FOV: 45 degrees; 2352 by 1568 pixels; color fundus photograph:
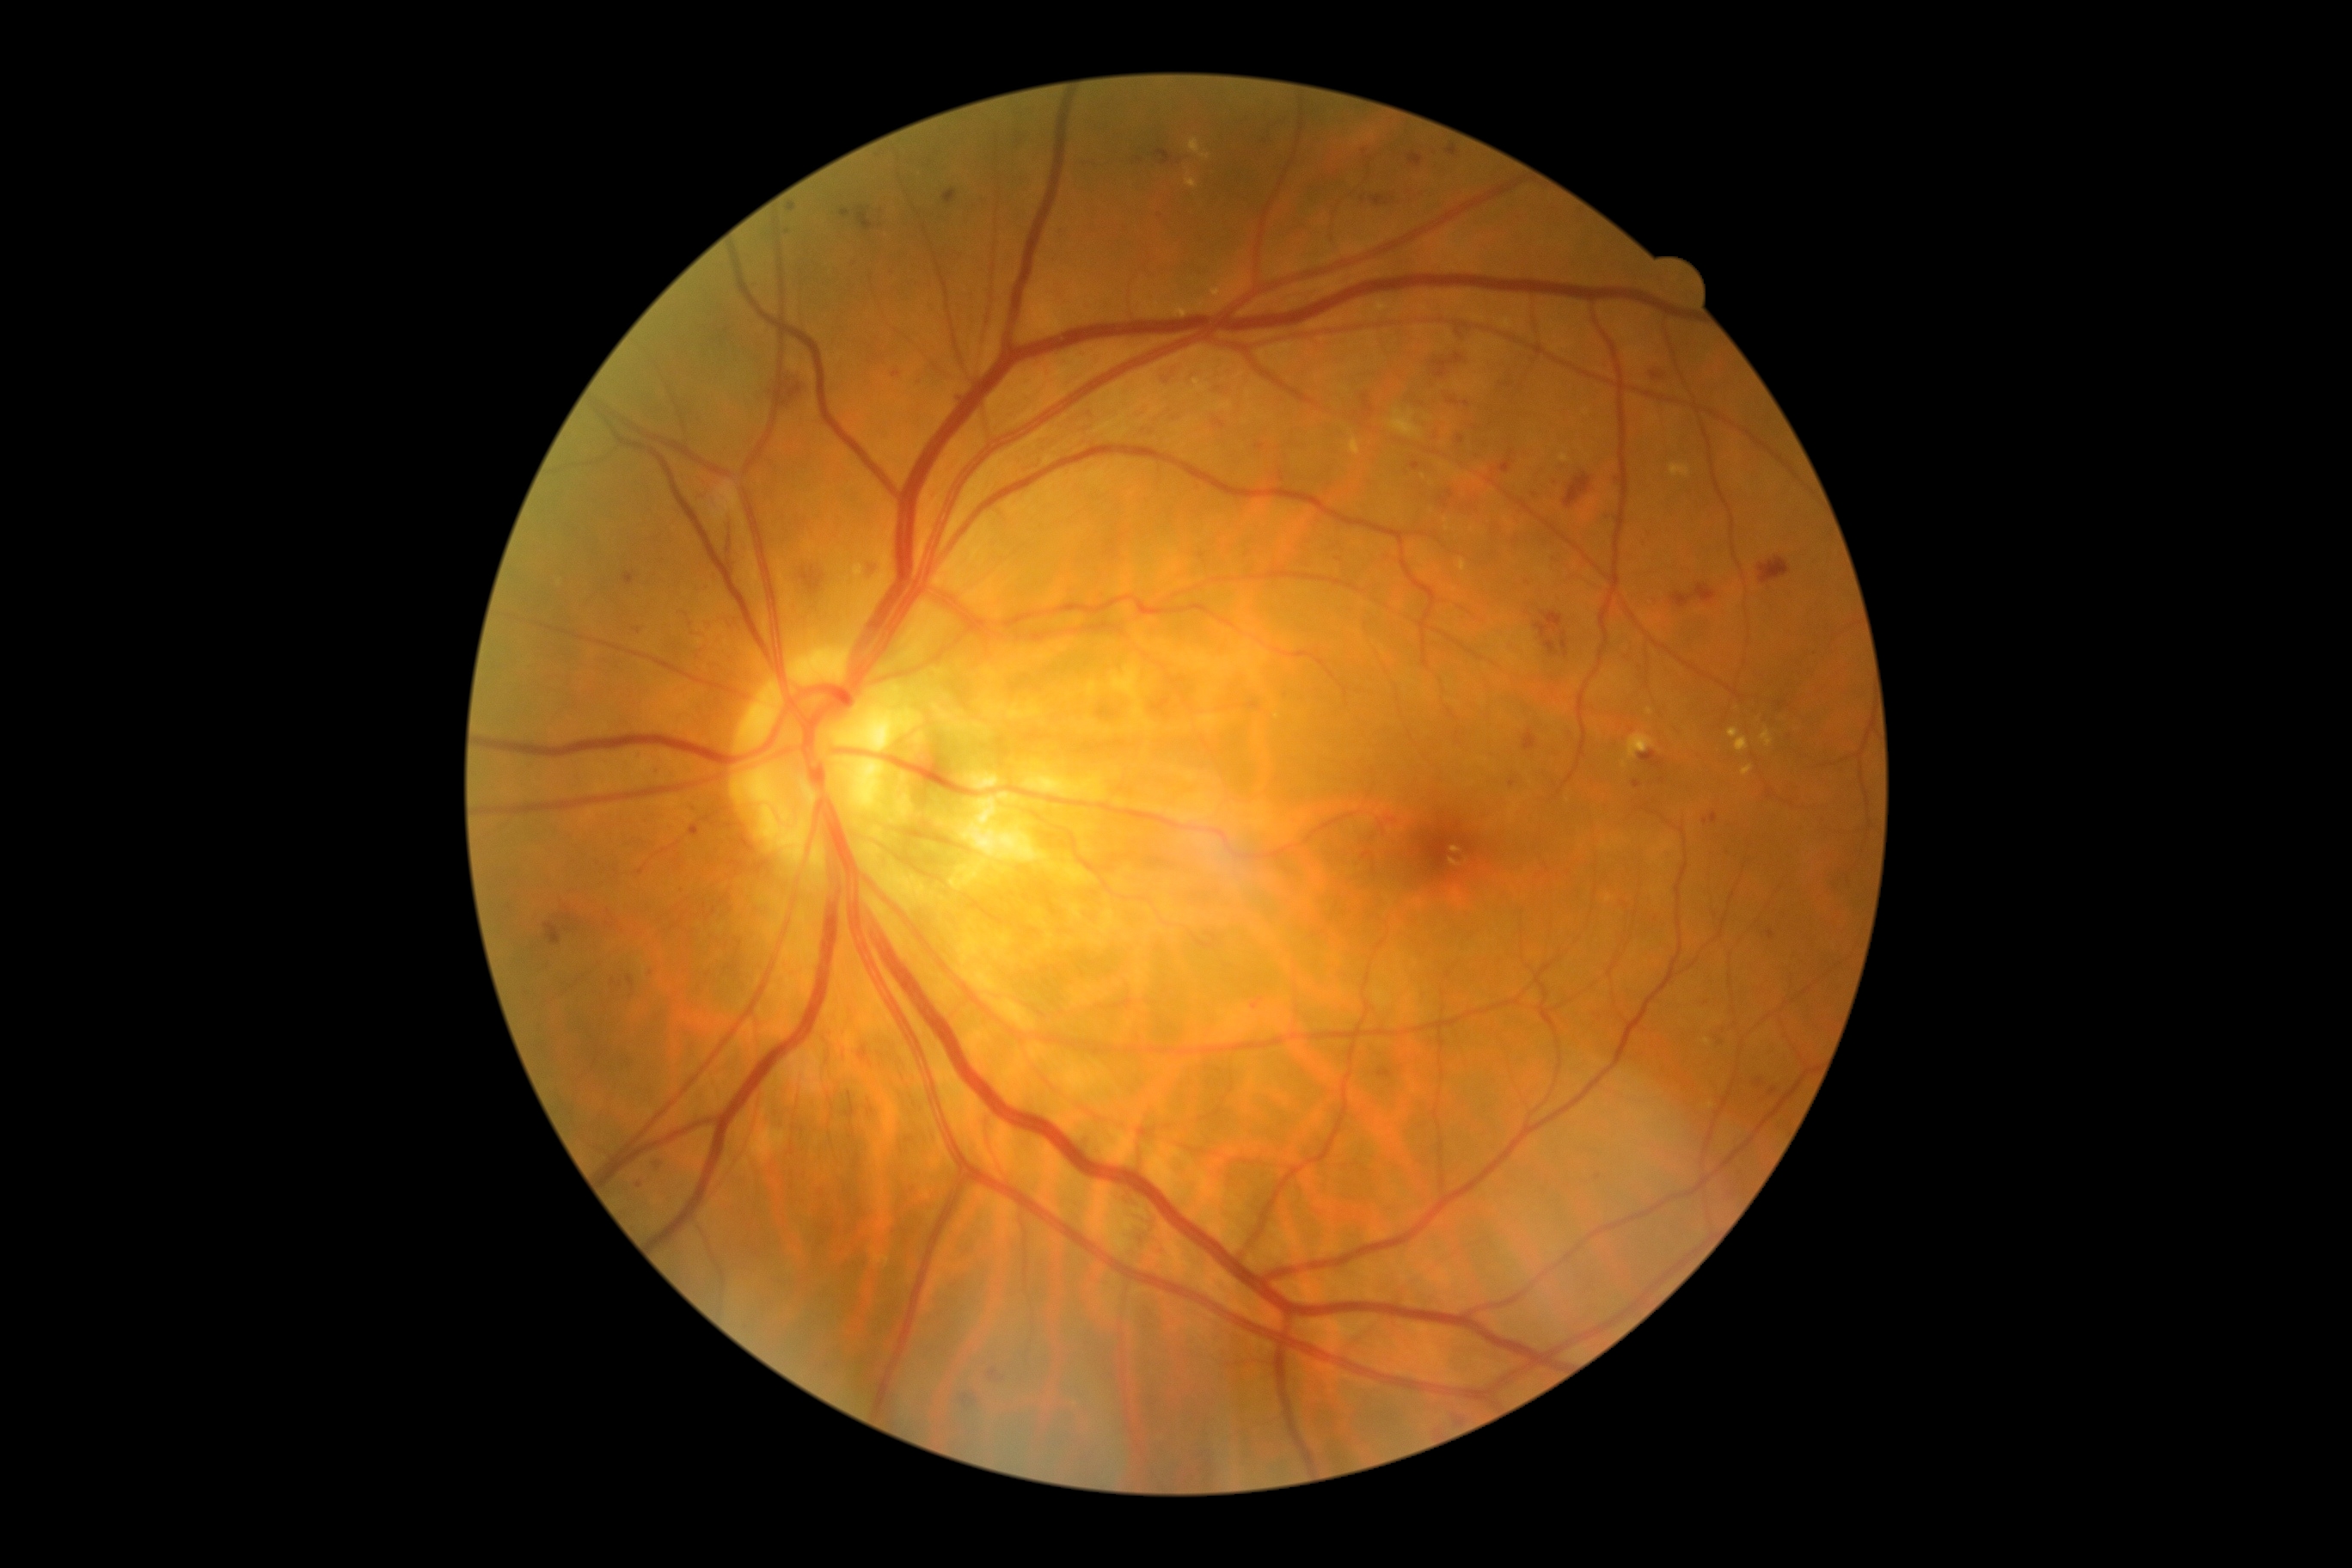
Diabetic retinopathy grade: 2; non-proliferative diabetic retinopathy
Representative lesions:
- hard exudates (more not shown): bbox(1670, 463, 1691, 479), bbox(1627, 735, 1655, 761), bbox(1607, 895, 1612, 903), bbox(1449, 859, 1461, 866), bbox(852, 563, 864, 577), bbox(1461, 560, 1467, 573), bbox(1729, 728, 1741, 738), bbox(1761, 730, 1773, 749)
- Hard exudates (small, approximate centers) near [1447,528], [1649,712], [1711,1106], [1446,521]
- microaneurysms (more not shown): bbox(1378, 1069, 1392, 1079), bbox(623, 573, 635, 587), bbox(1156, 150, 1173, 166), bbox(1409, 152, 1424, 168), bbox(878, 202, 885, 217), bbox(1457, 436, 1464, 444), bbox(1639, 750, 1665, 769), bbox(1767, 790, 1773, 799), bbox(891, 271, 895, 279), bbox(1256, 444, 1265, 450), bbox(1548, 477, 1557, 486), bbox(842, 211, 850, 217), bbox(787, 204, 797, 212)
- Microaneurysms (small, approximate centers) near [1779,704], [1783,1099], [655,772], [1467,404], [680,890], [1363,200]